Modified Davis classification: 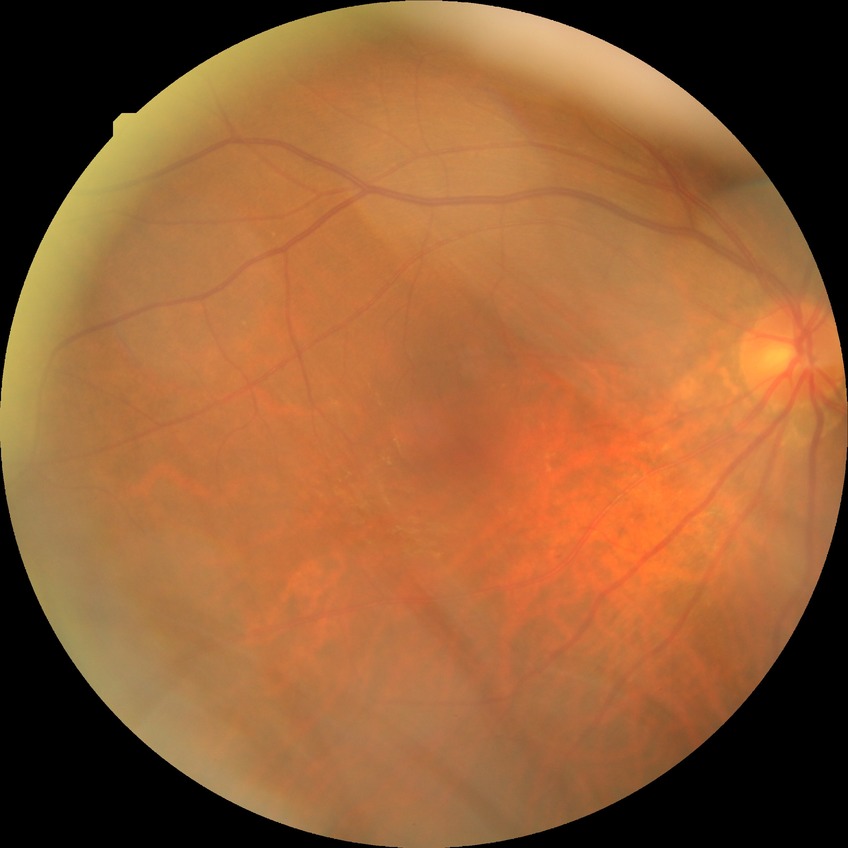 Modified Davis classification: no diabetic retinopathy.